Captured with the Clarity RetCam 3 (130° field of view); pediatric wide-field fundus photograph: 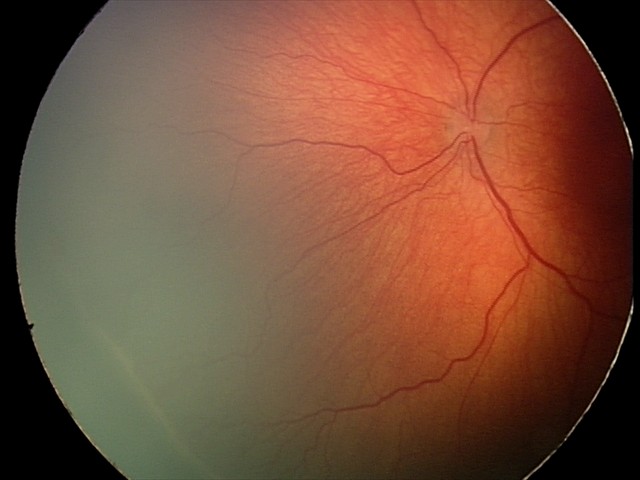

No plus disease.
Screening series with retinopathy of prematurity (ROP) stage 2 — ridge with height and width at the demarcation line.